2346x1568.
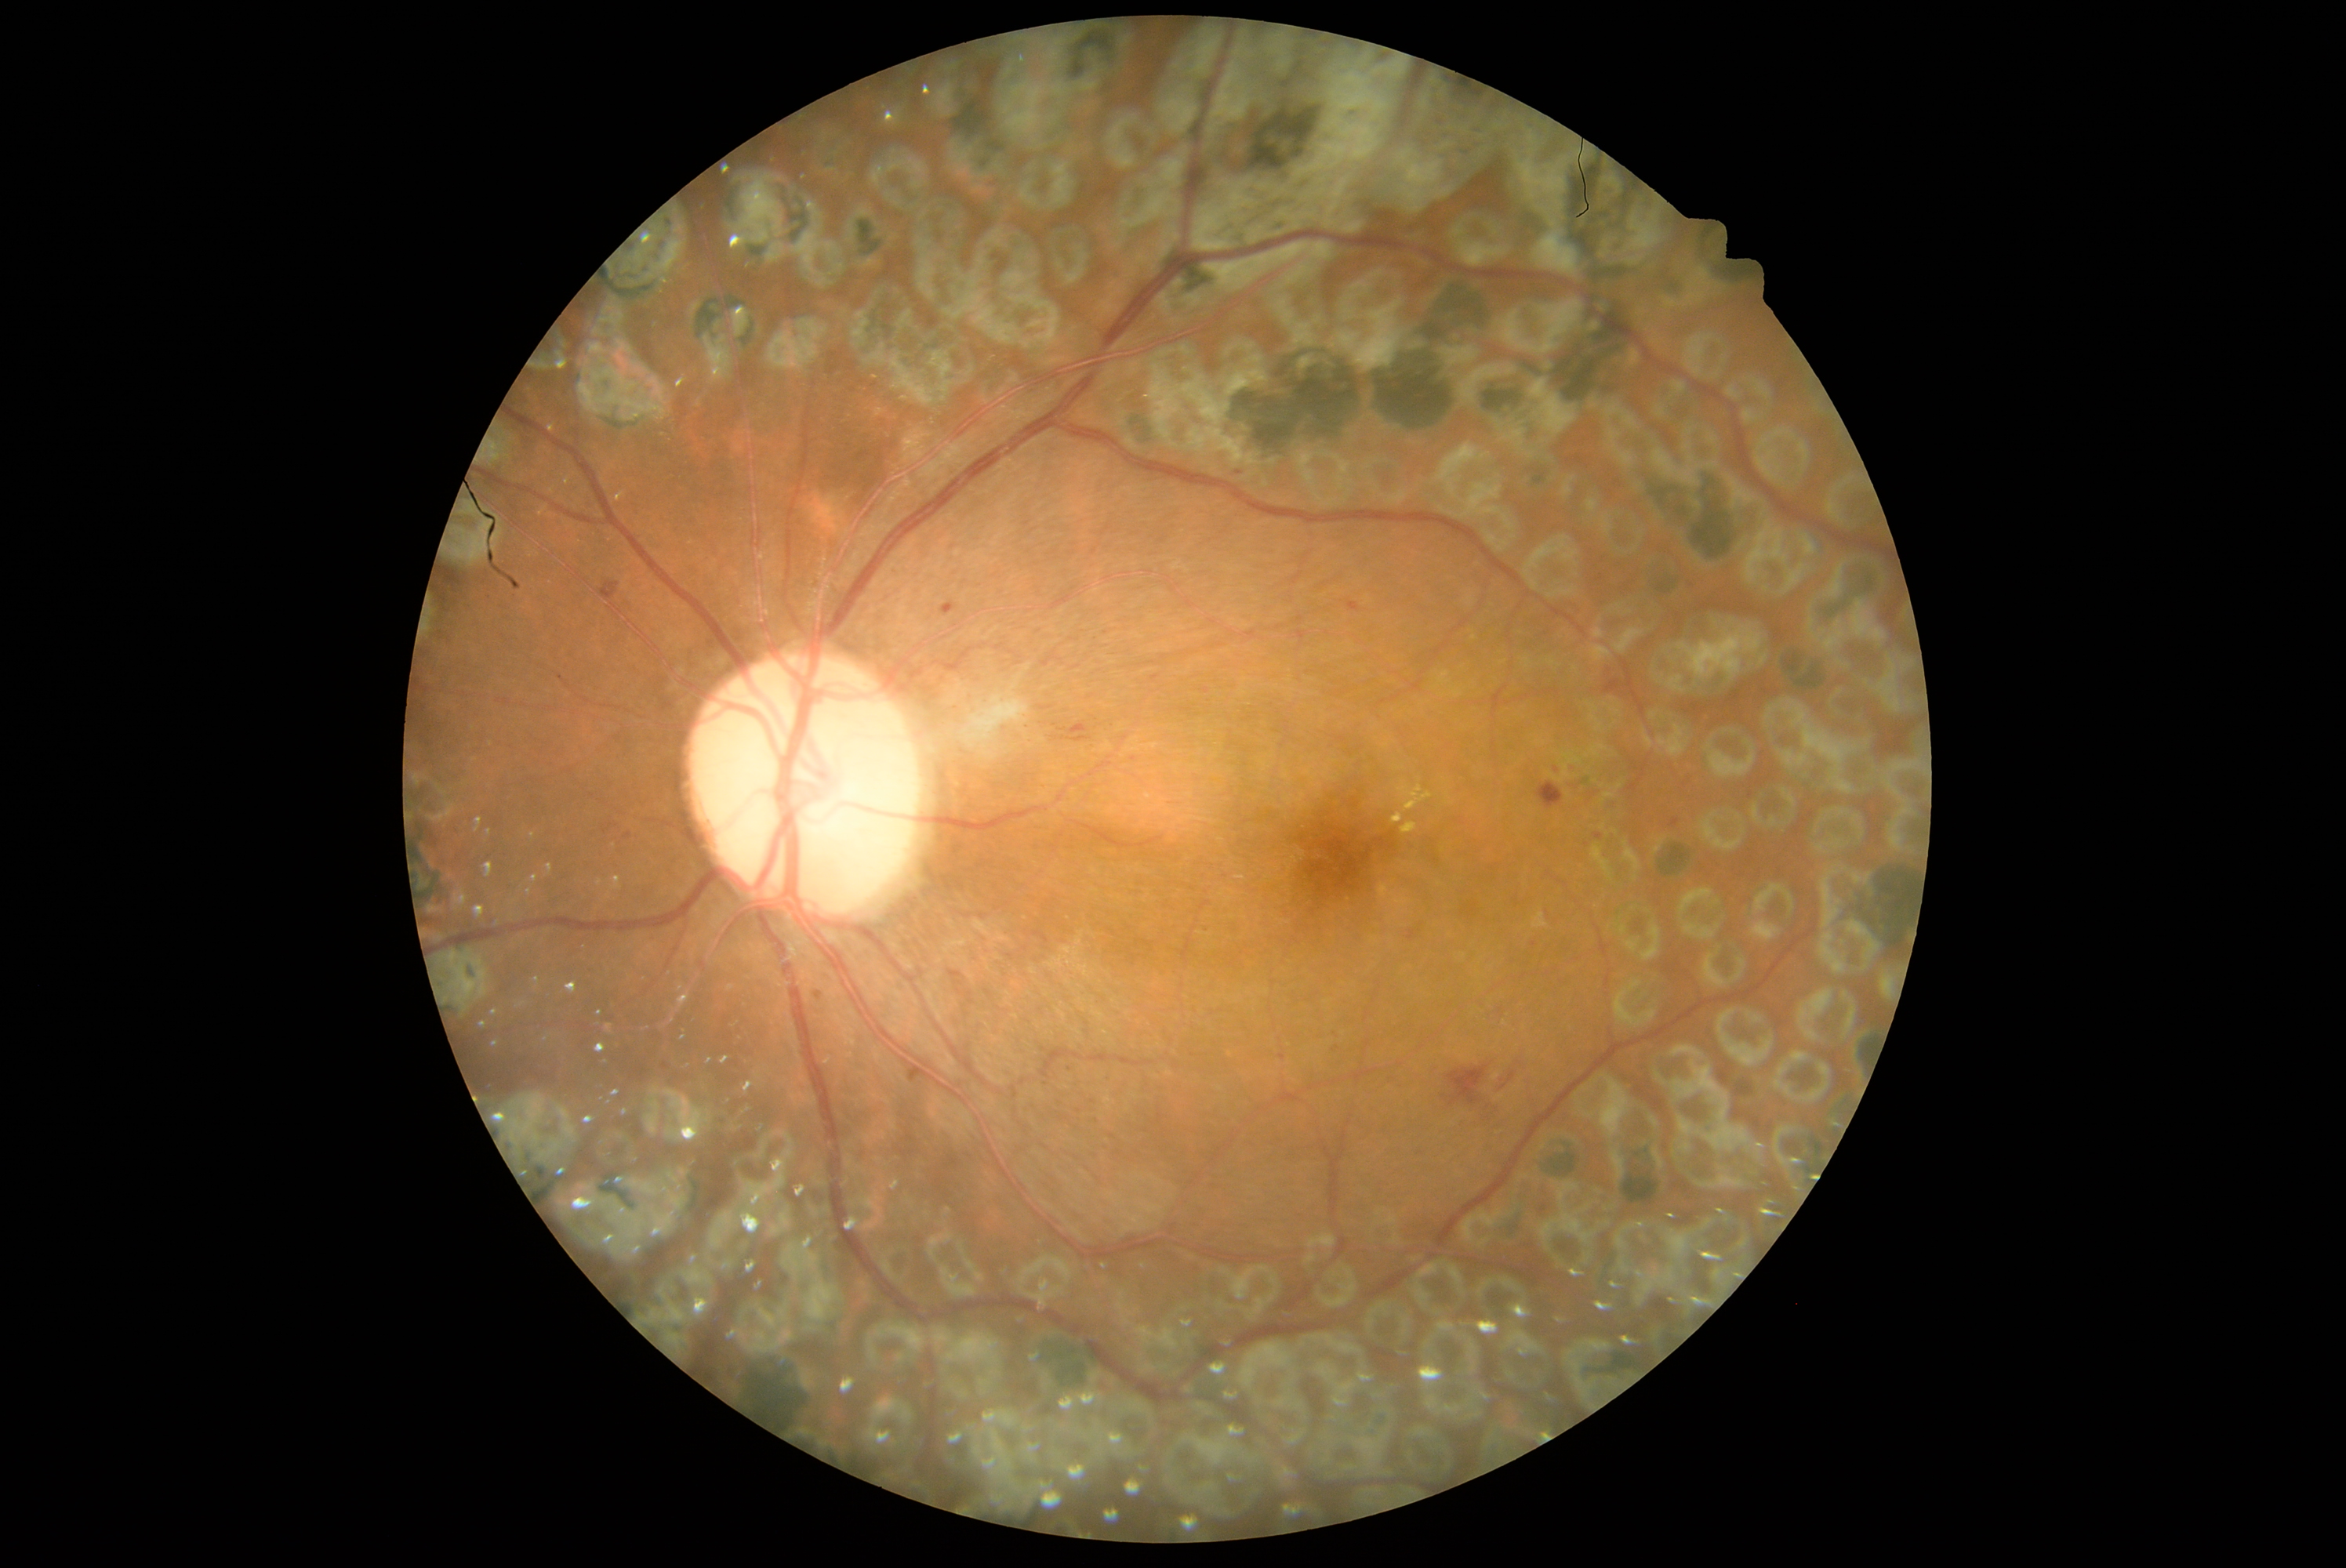 {
  "dr_grade": "grade 2 (moderate NPDR)"
}